200° FOV, ultra-widefield fundus mosaic.
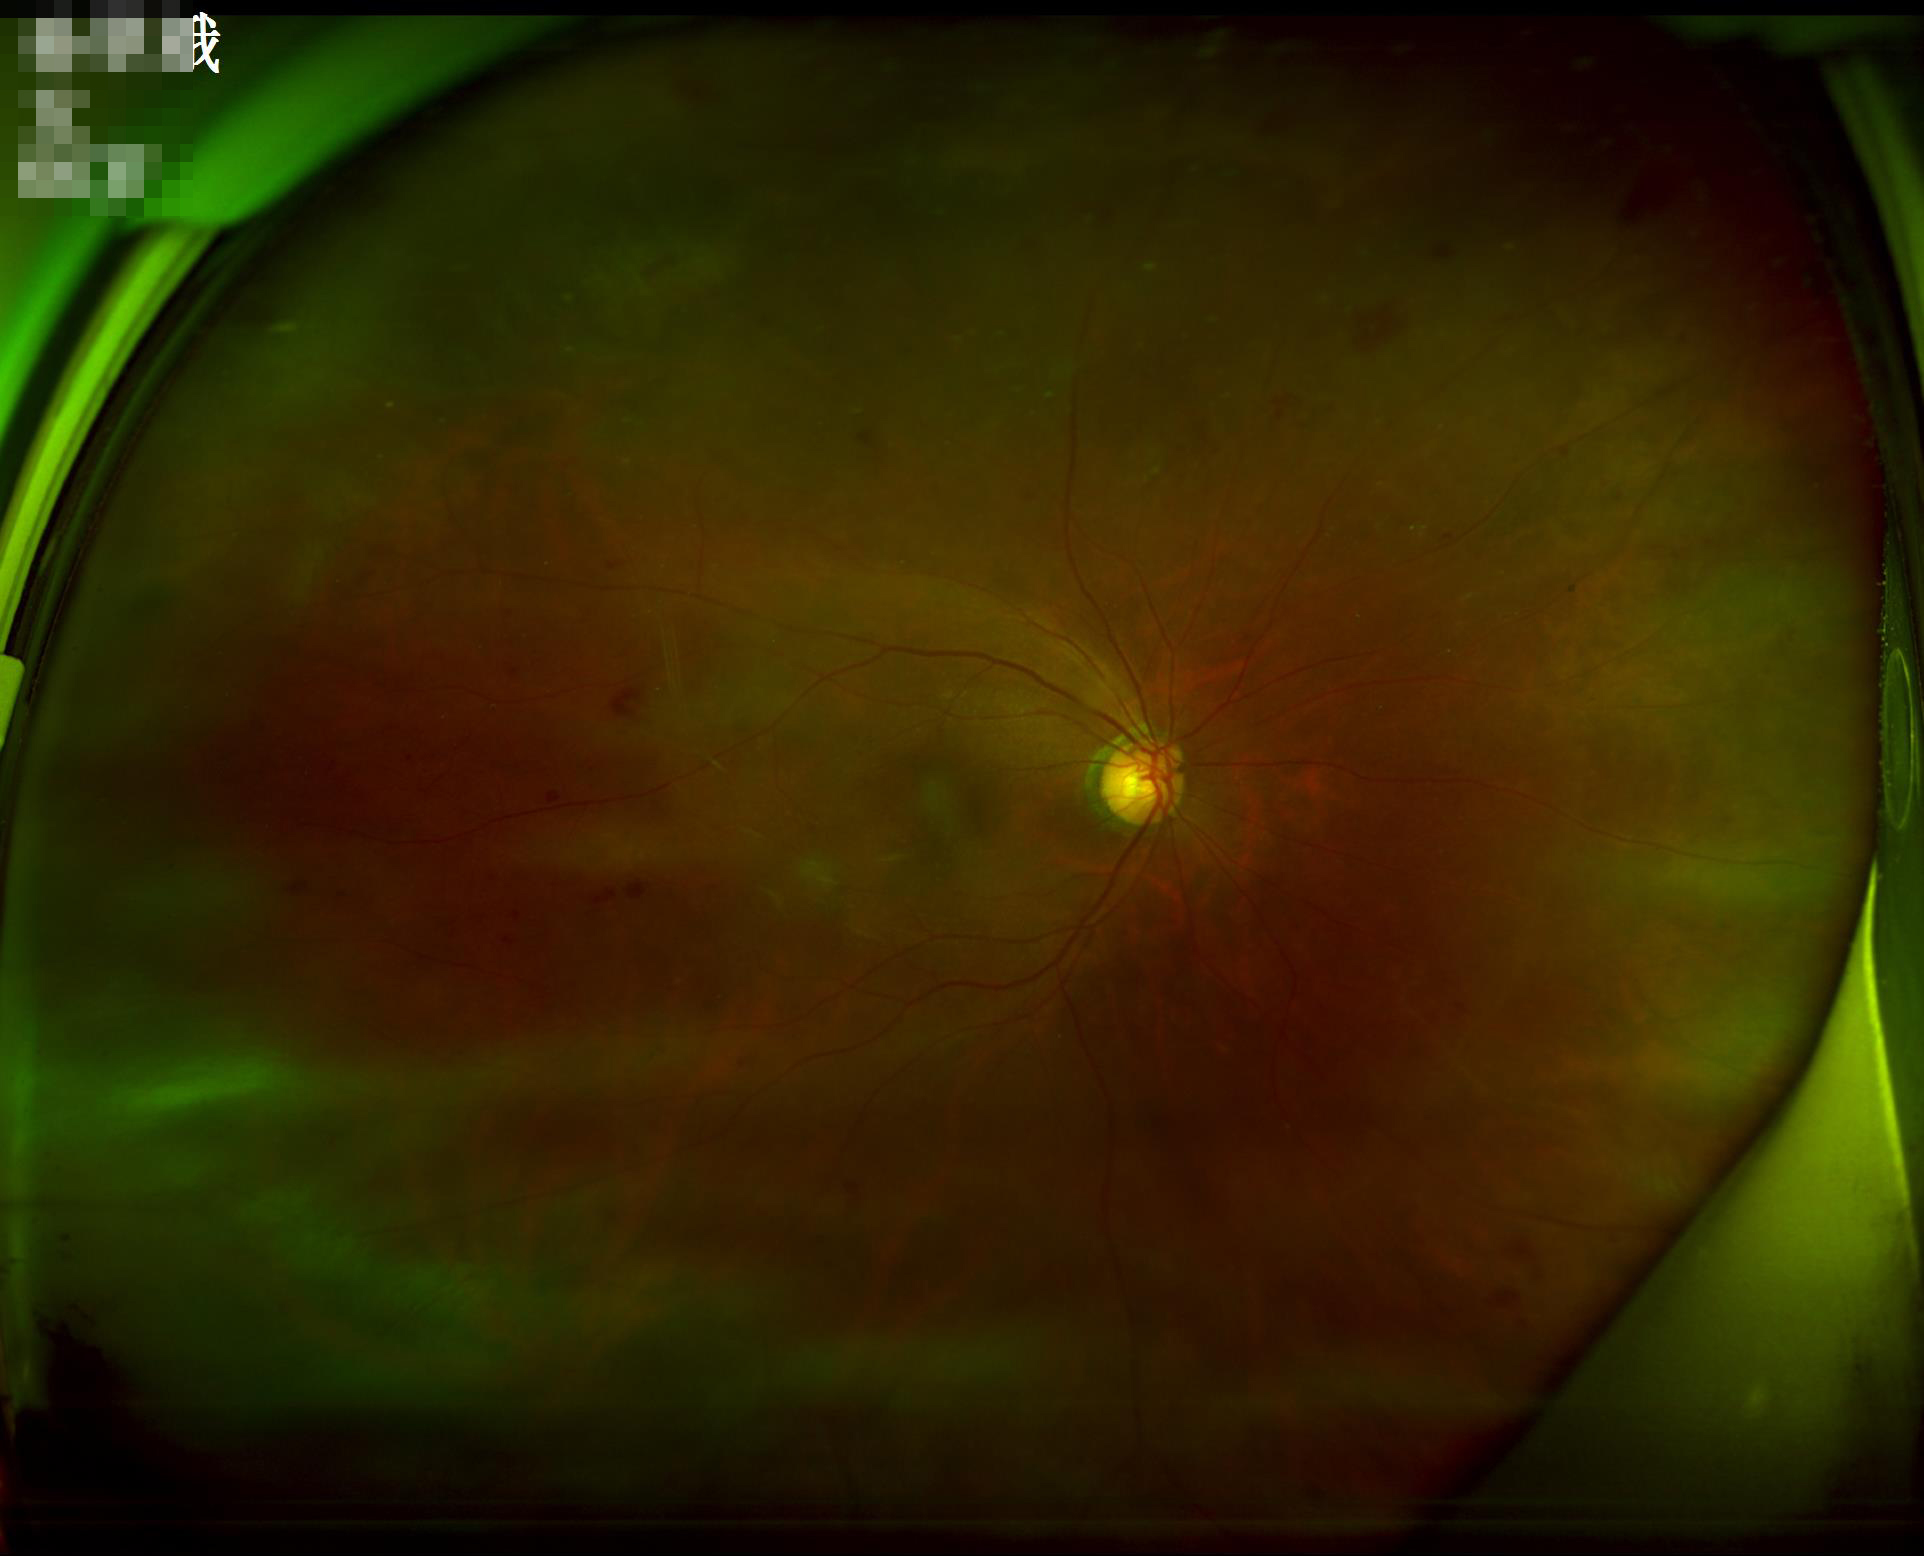 Reduced sharpness with visible blur.
Illumination is even.
Overall image quality is poor.
Vessels and details are readily distinguishable.